Acquired with a NIDEK AFC-230 — 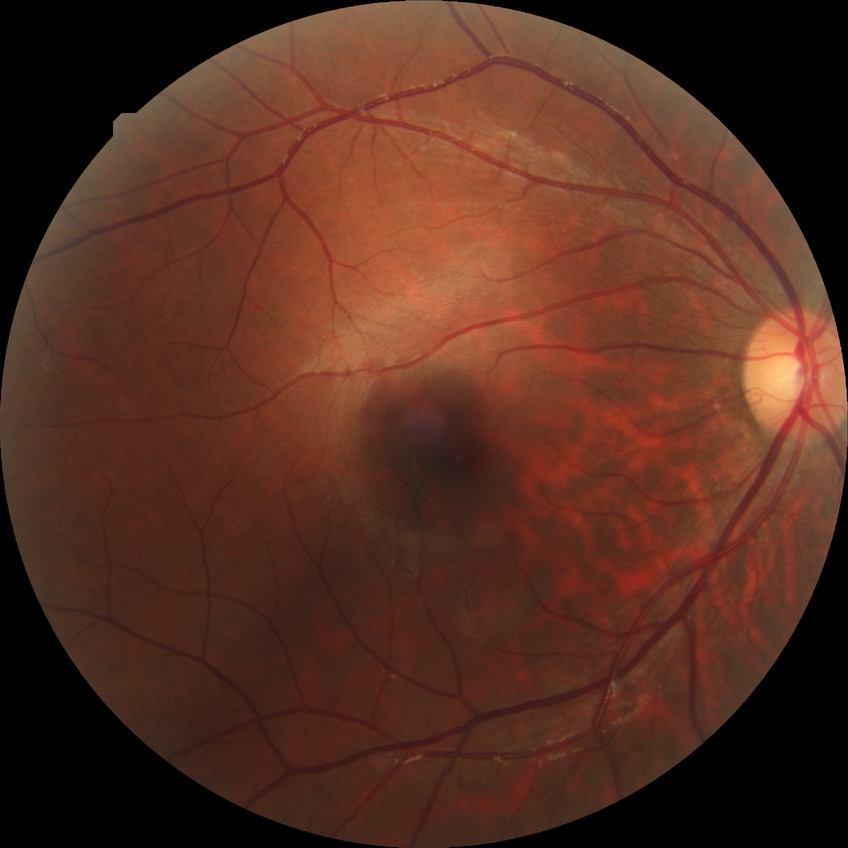

diabetic retinopathy (DR): NDR (no diabetic retinopathy).